Graded on the modified Davis scale: 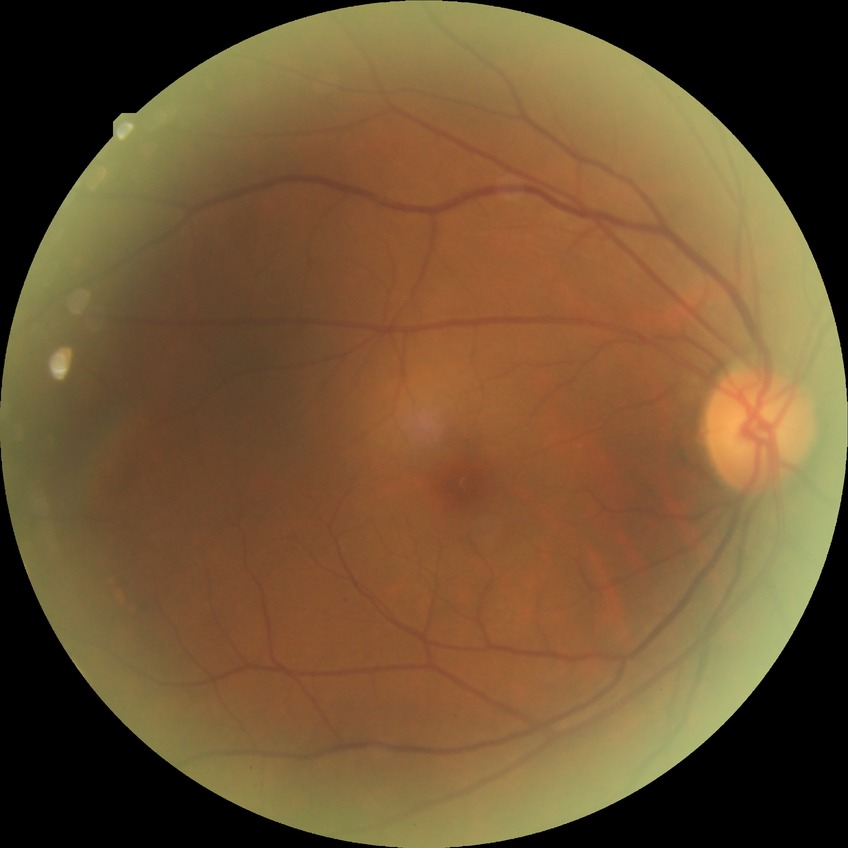
diabetic retinopathy (DR) = simple diabetic retinopathy (SDR).